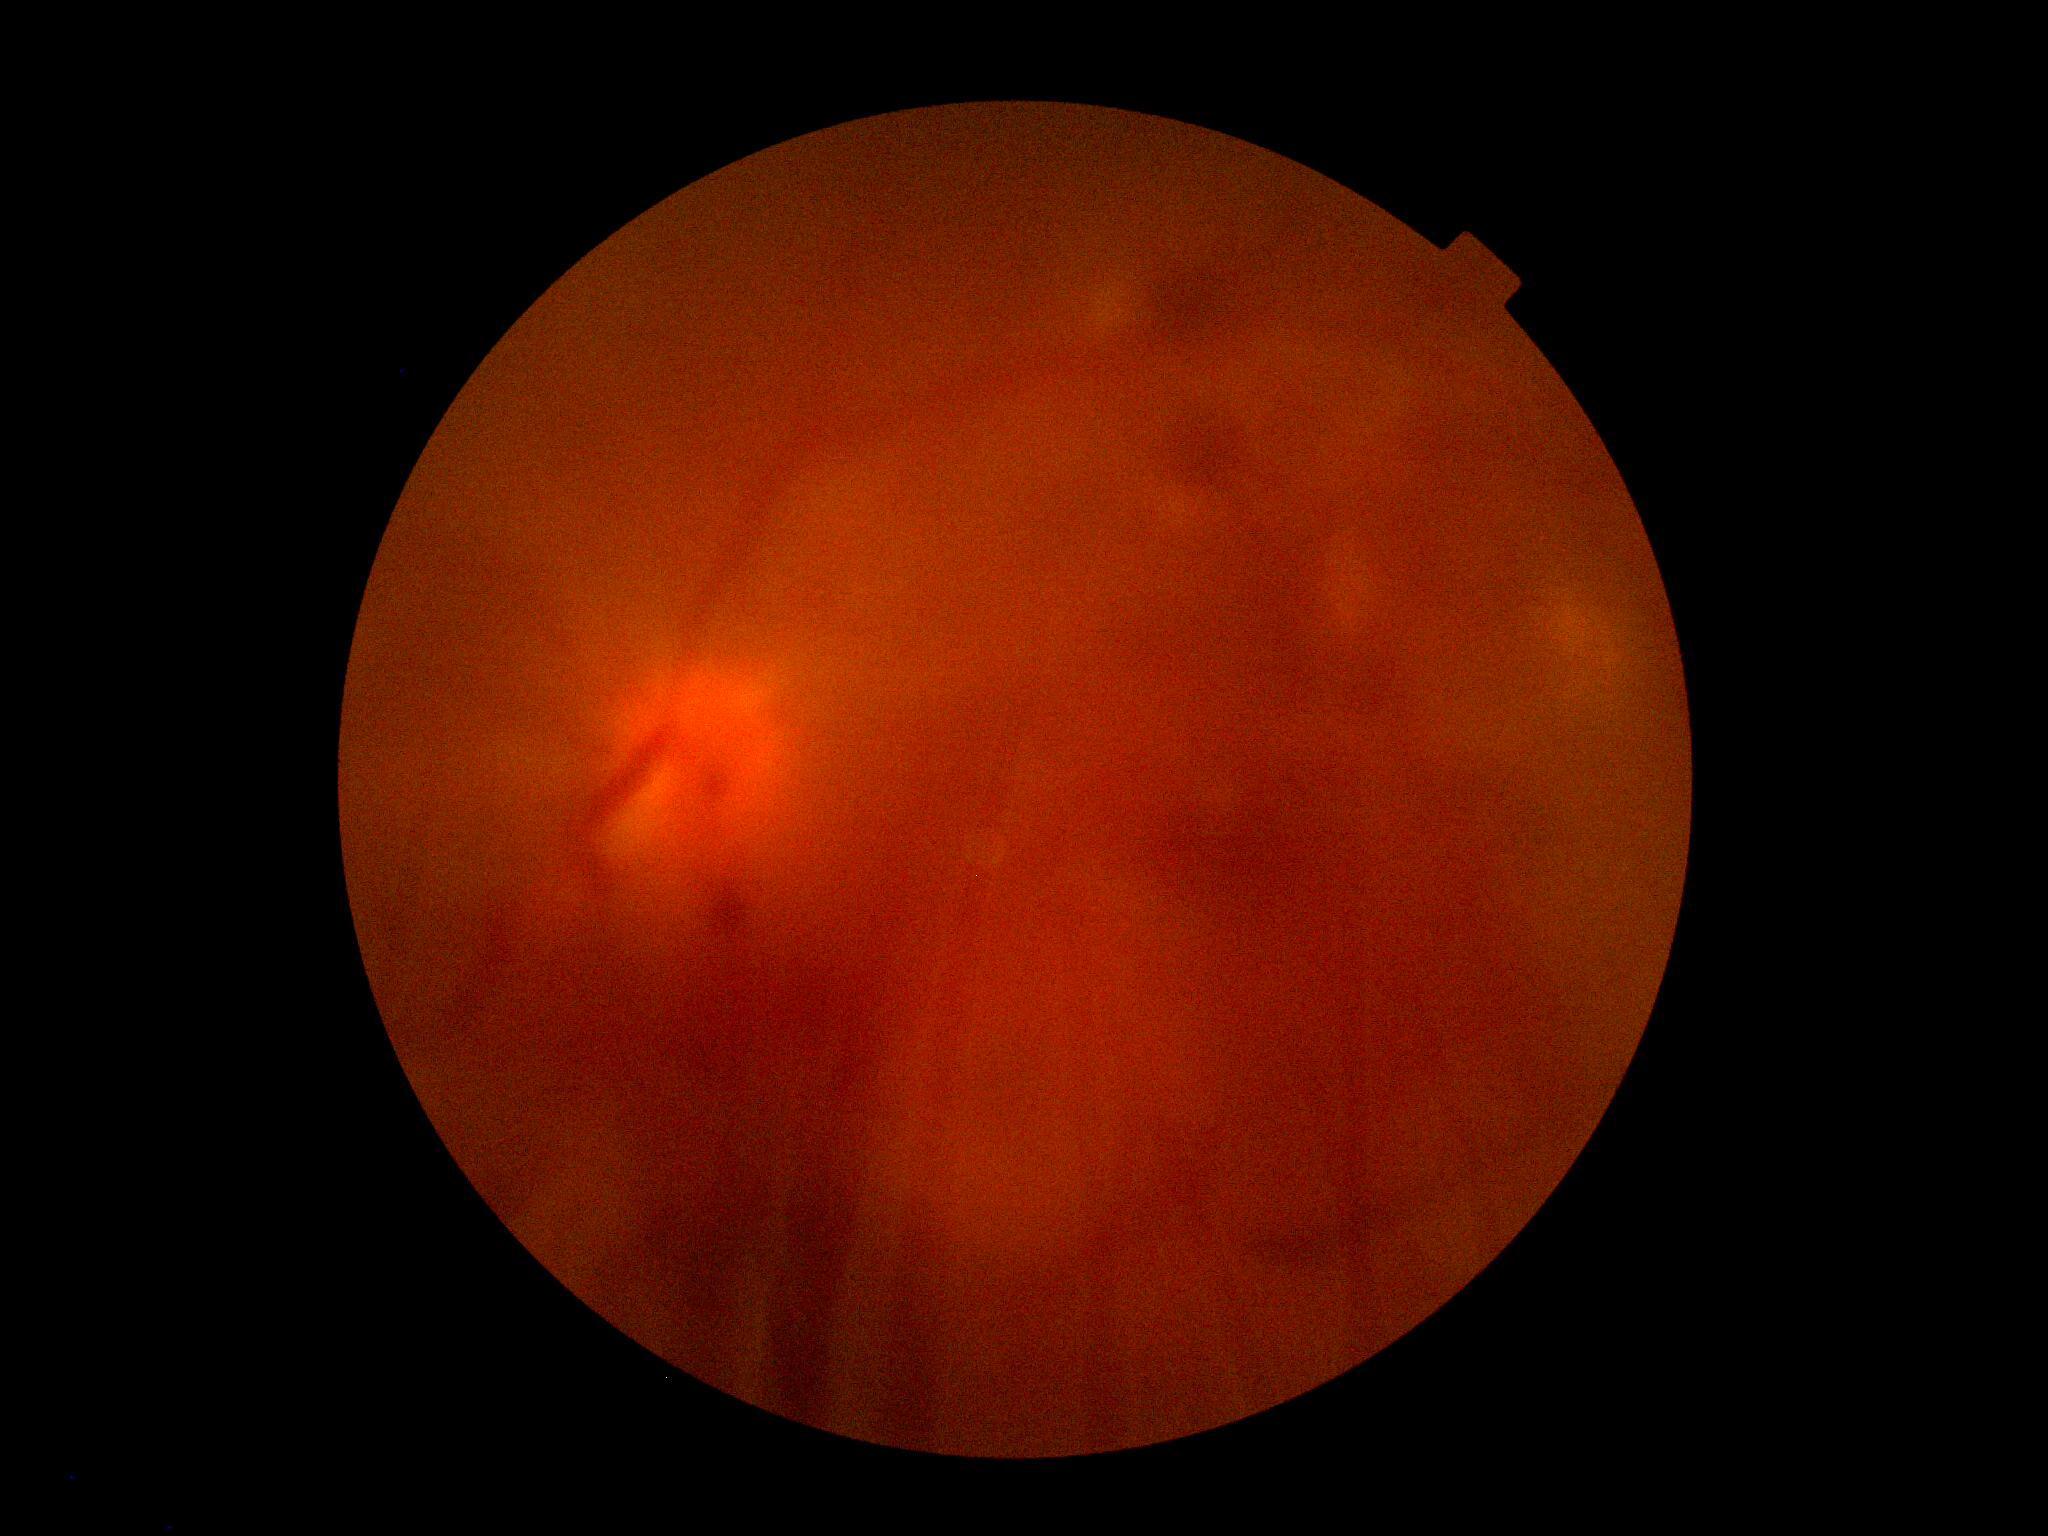
  dr_category: proliferative diabetic retinopathy
  dr_grade: PDR (grade 4)